Wide-field contact fundus photograph of an infant — 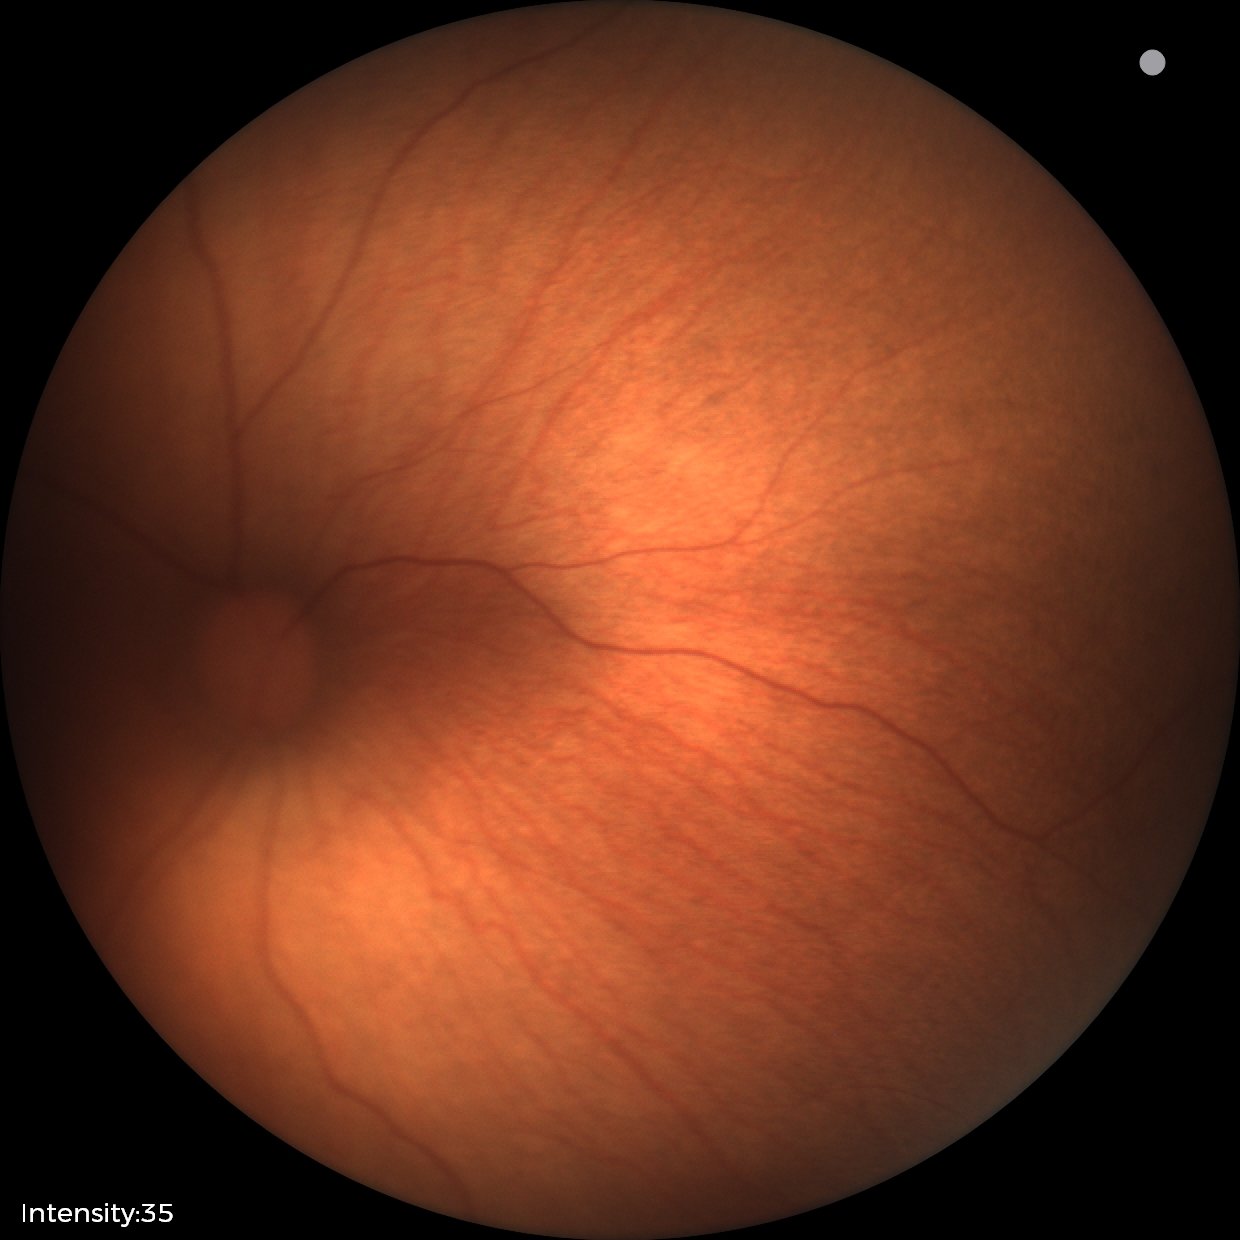 Assessment: physiological appearance with no retinal pathology.